Fundus photo; Davis DR grading; 45 degree fundus photograph: 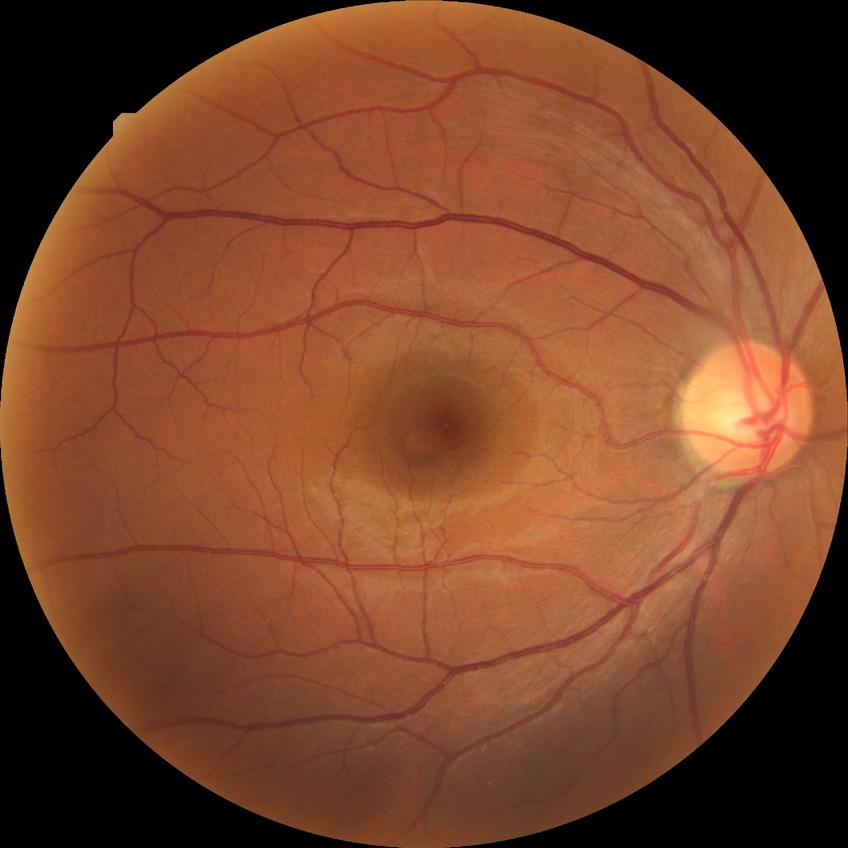
• diabetic retinopathy (DR): no diabetic retinopathy (NDR)